No pharmacologic dilation. 848 by 848 pixels. NIDEK AFC-230. FOV: 45 degrees. Retinal fundus photograph:
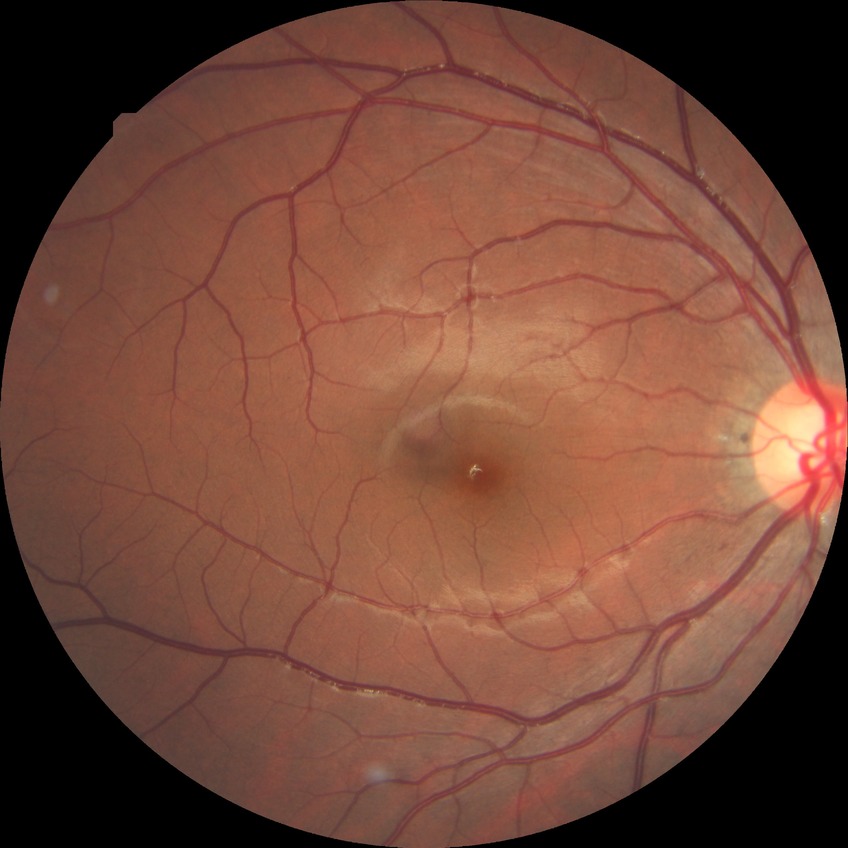
Diabetic retinopathy (DR) is NDR (no diabetic retinopathy).